Macula-centered — 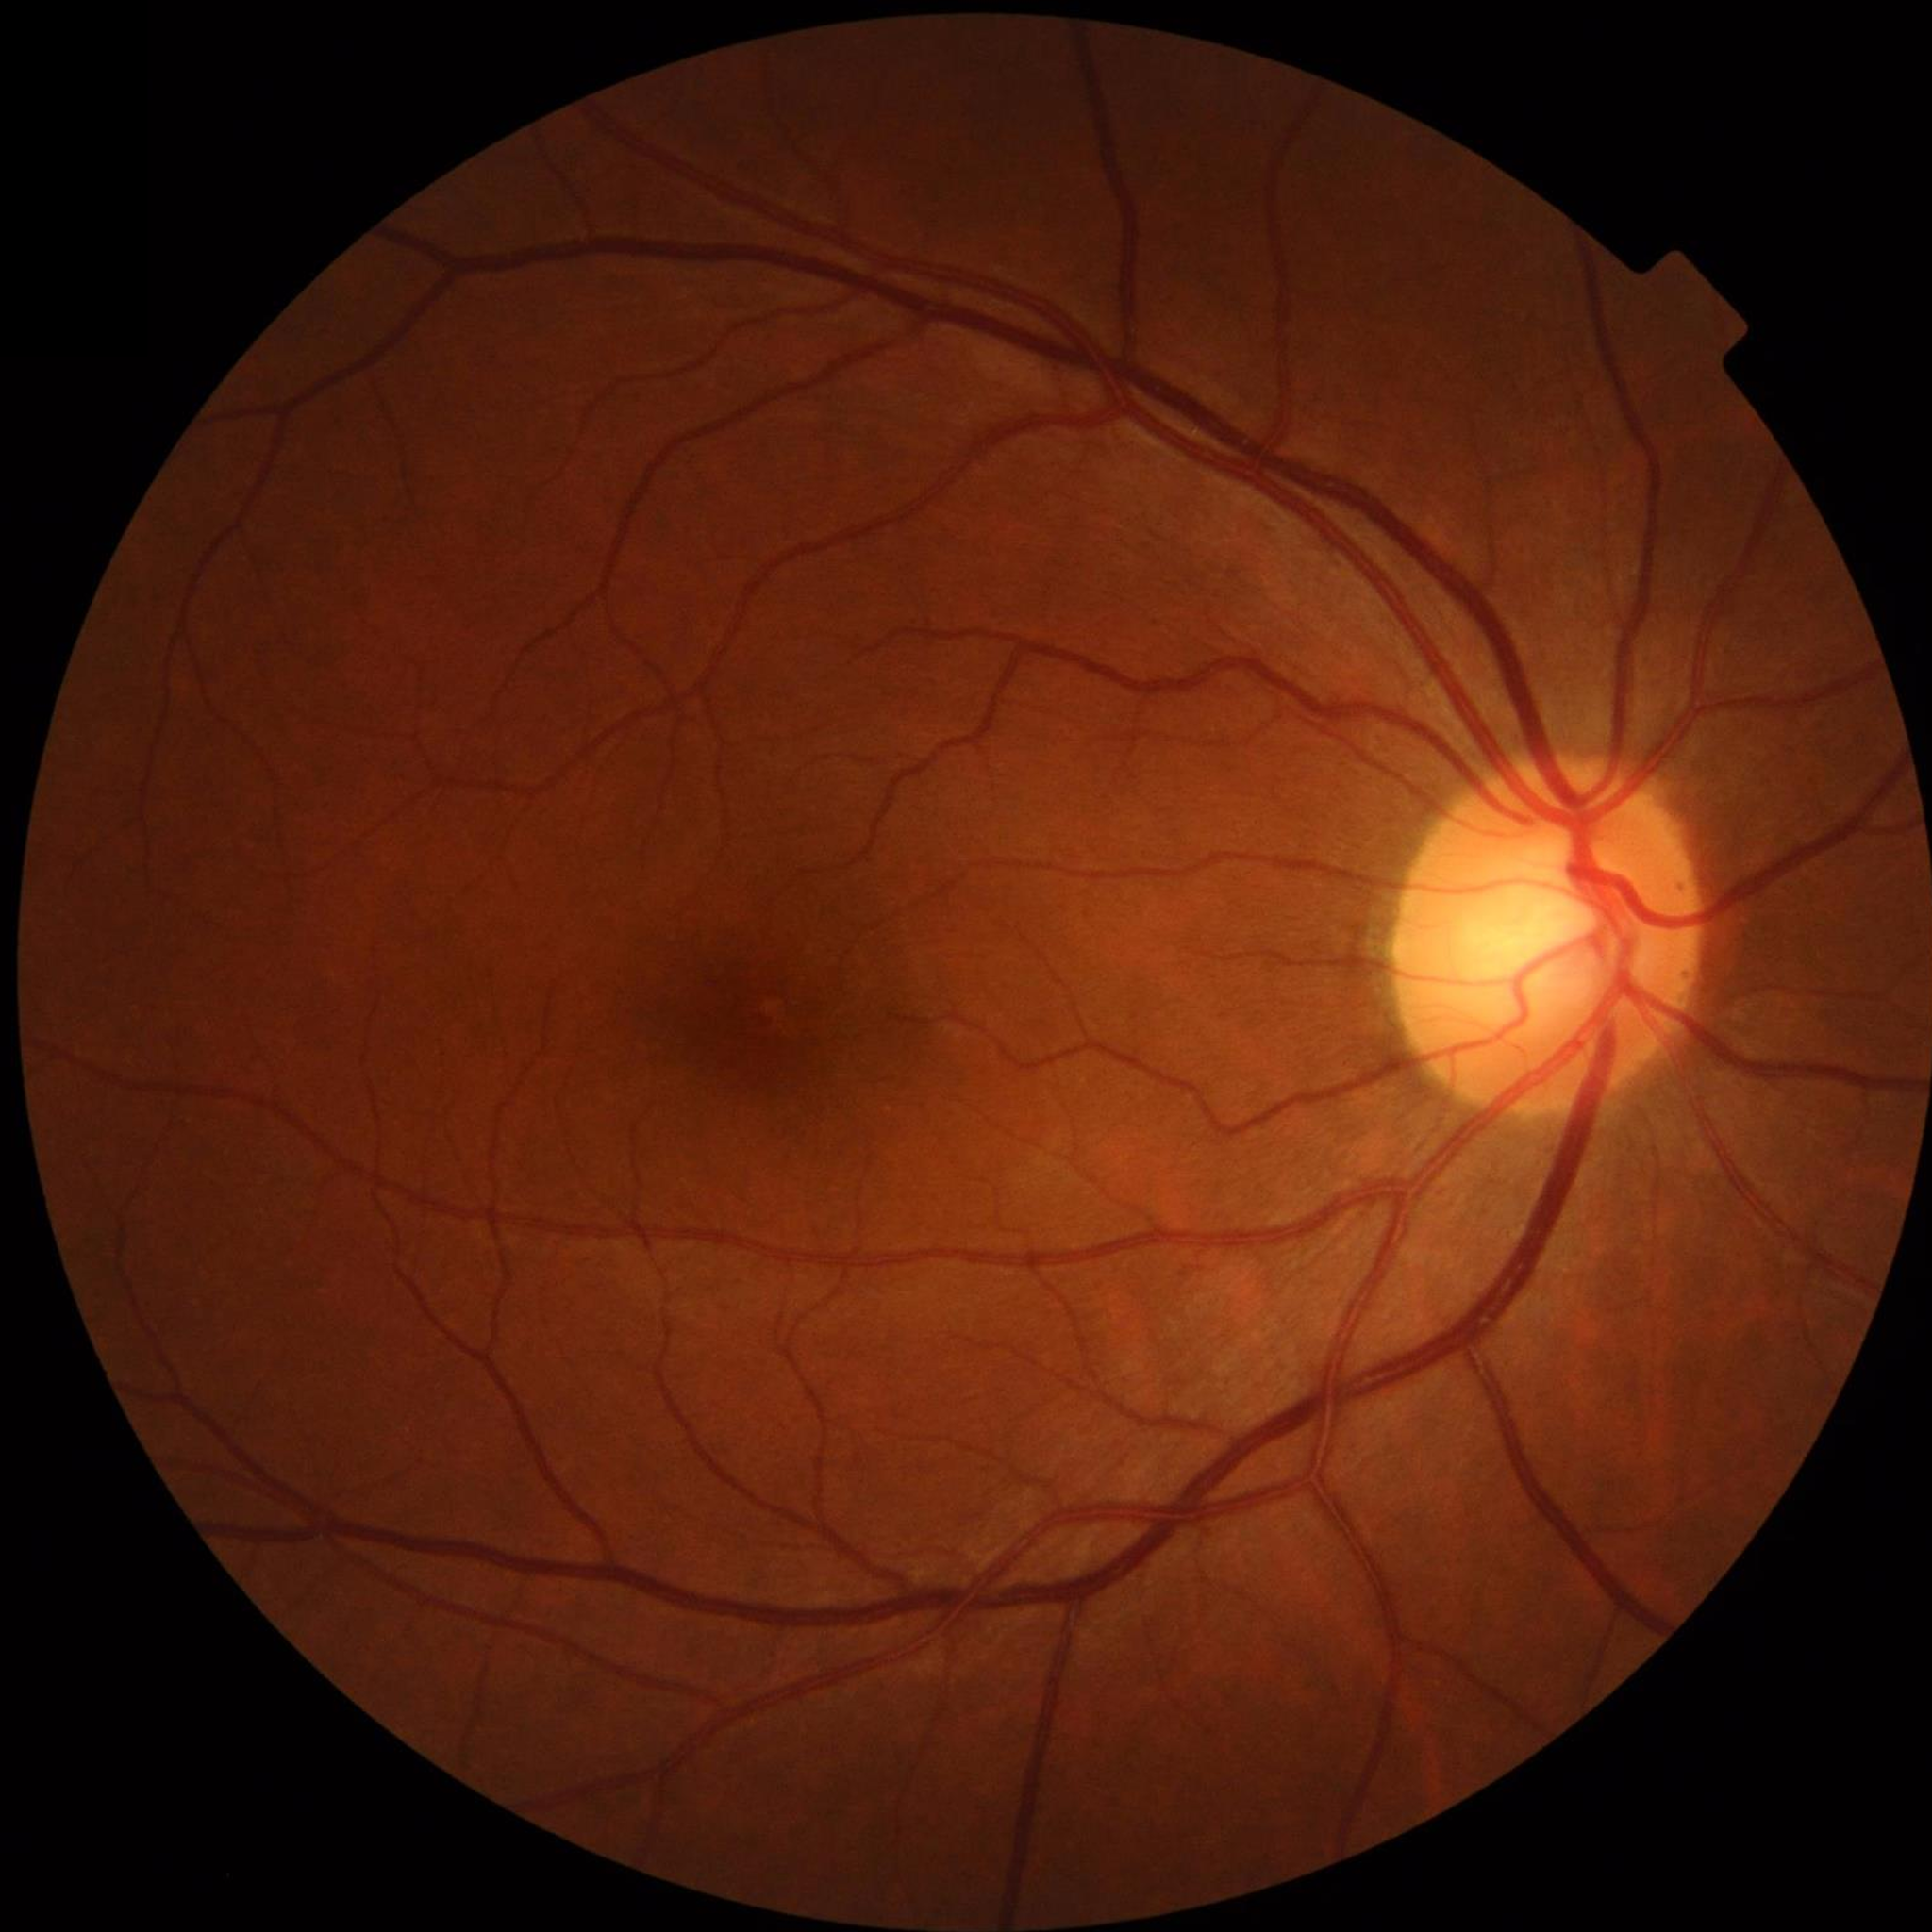

No signs of AMD, diabetic retinopathy, or glaucoma.